Graded on the modified Davis scale · nonmydriatic:
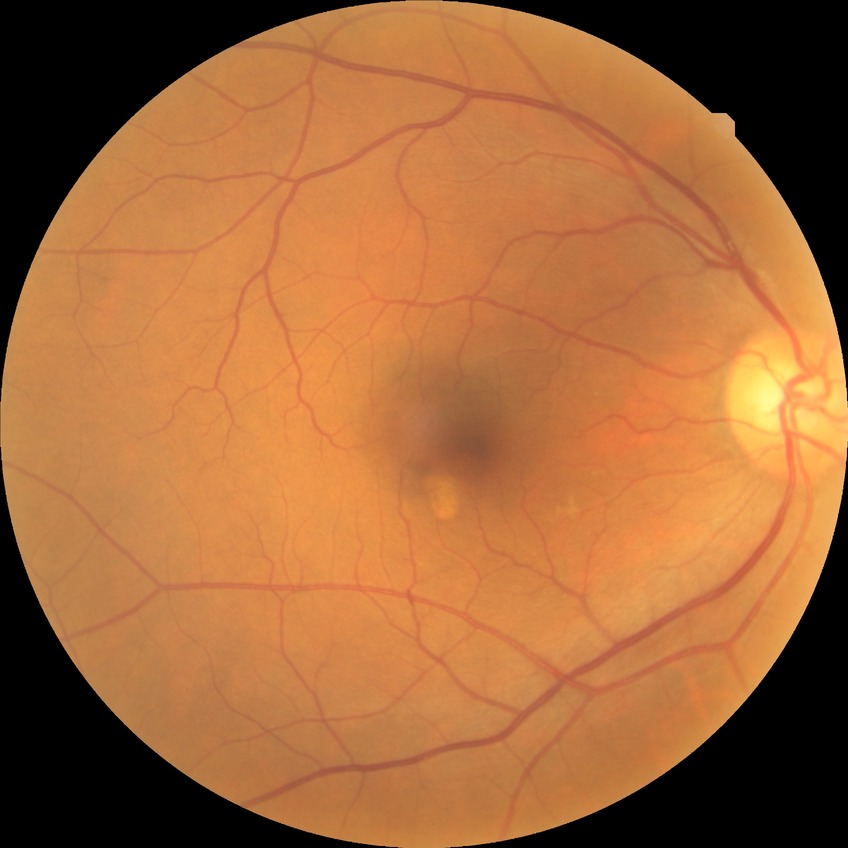   davis_grade: NDR